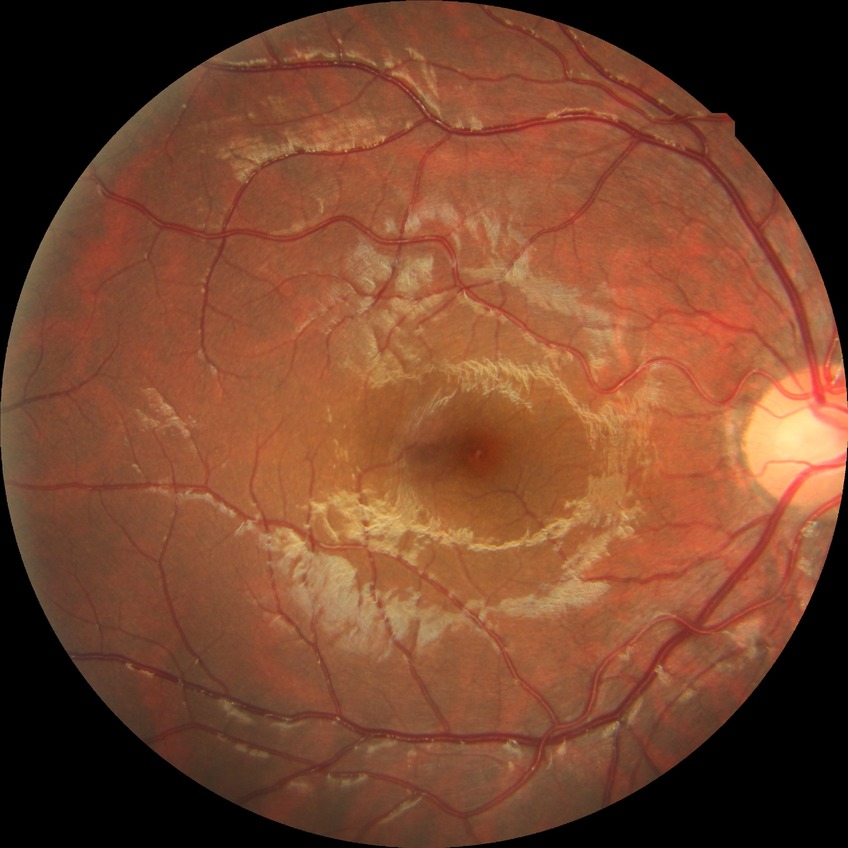

DR grade: NDR, DR impression: no DR findings.